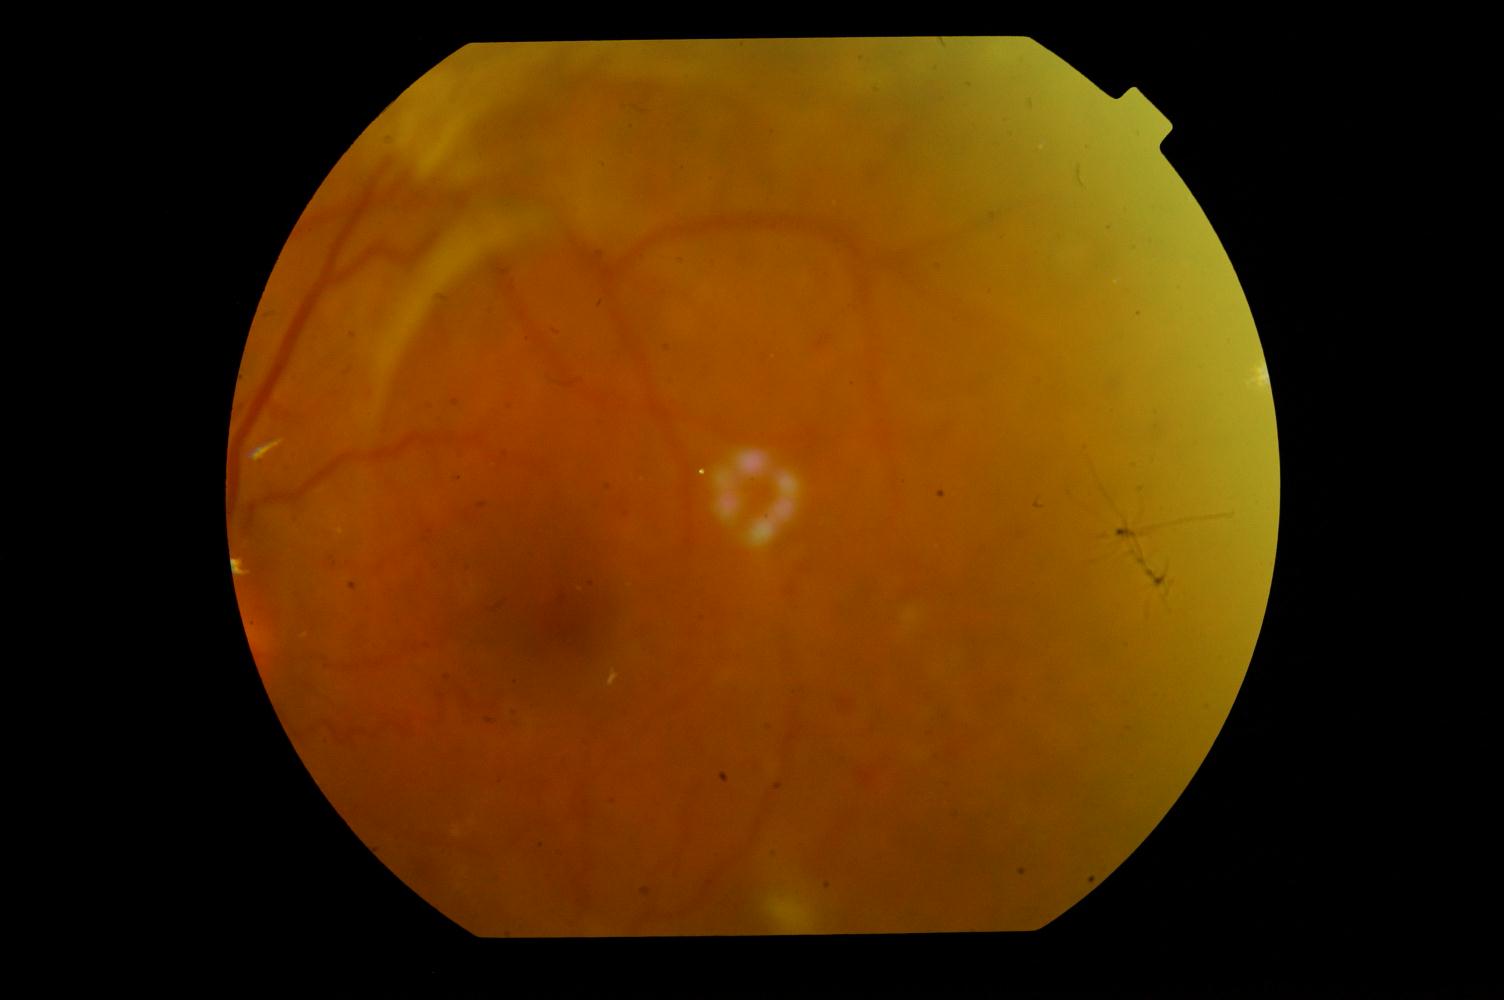 The image shows diabetic retinopathy (DR).